735x723px; CFP:
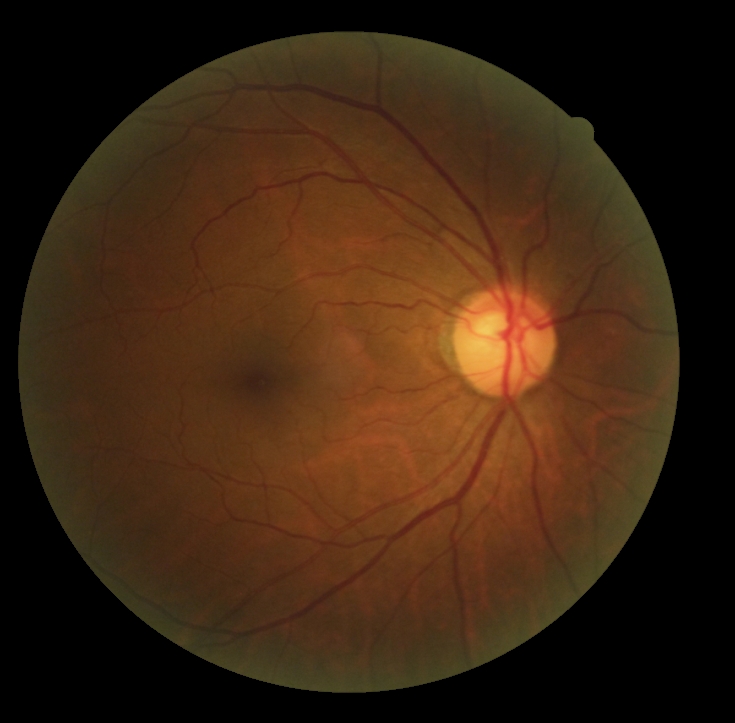
DR severity: grade 0 (no apparent retinopathy) — no visible signs of diabetic retinopathy